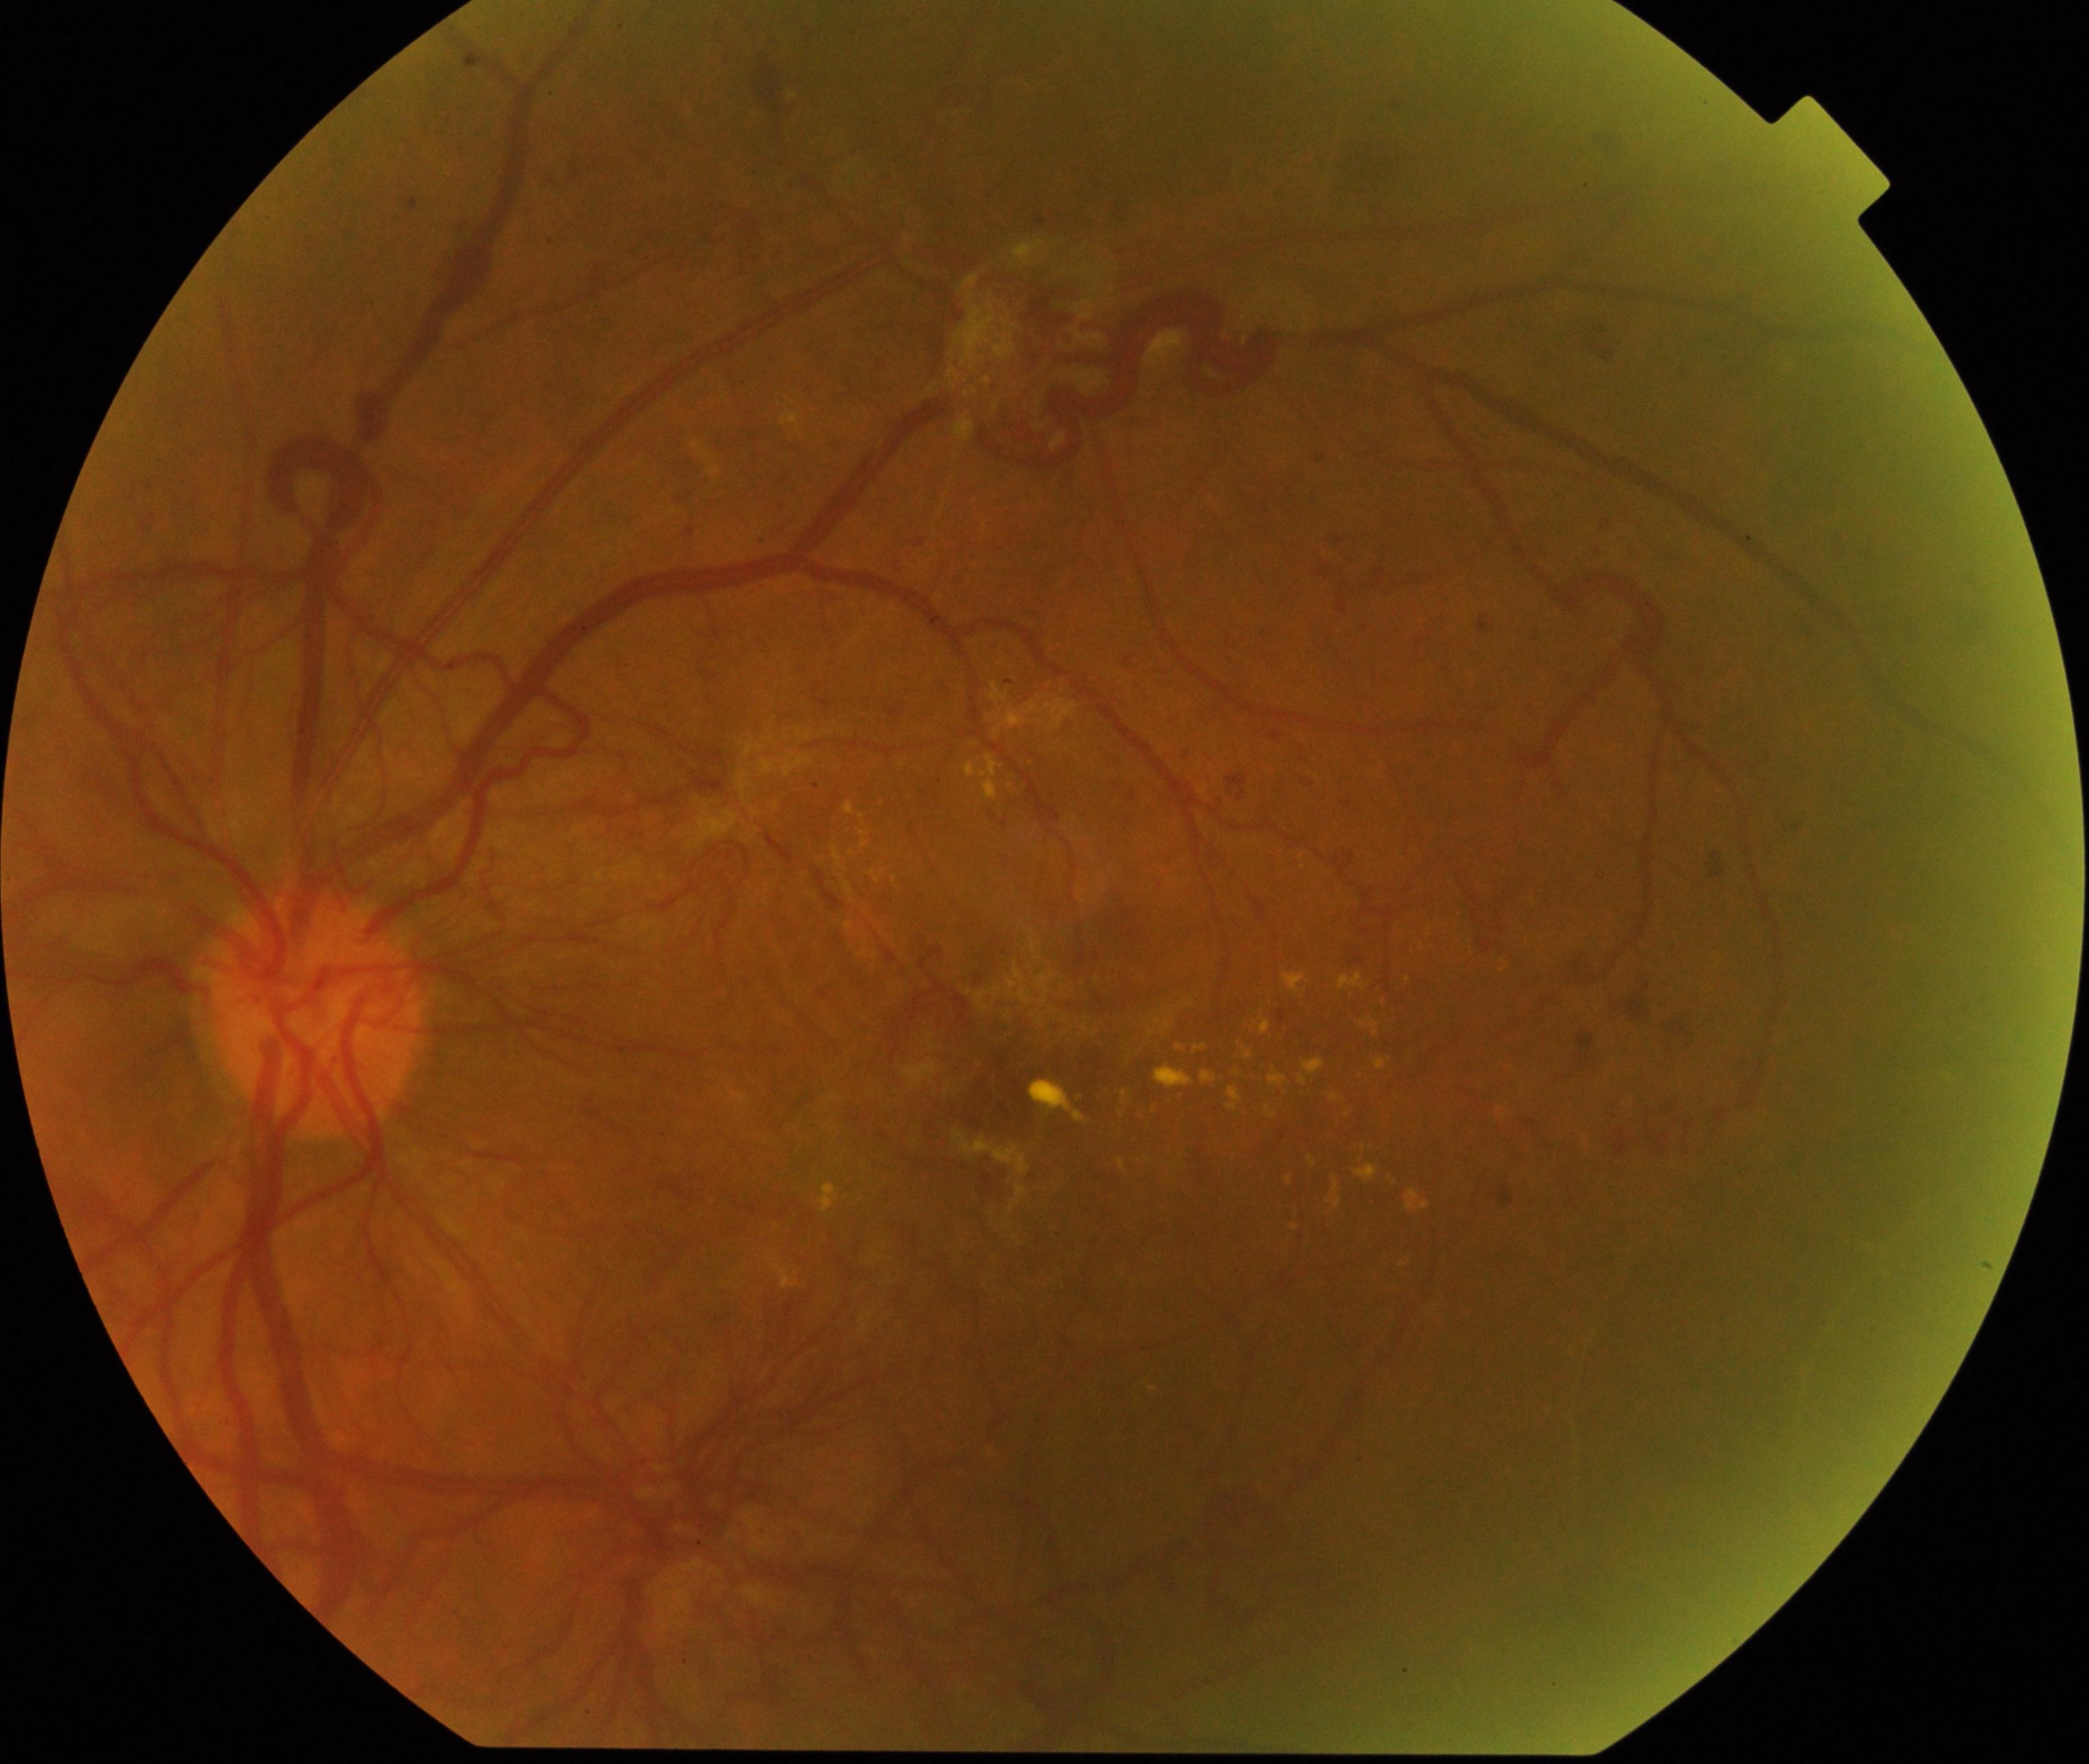 This fundus photograph shows severe non-proliferative or proliferative diabetic retinopathy.